Modified Davis grading:
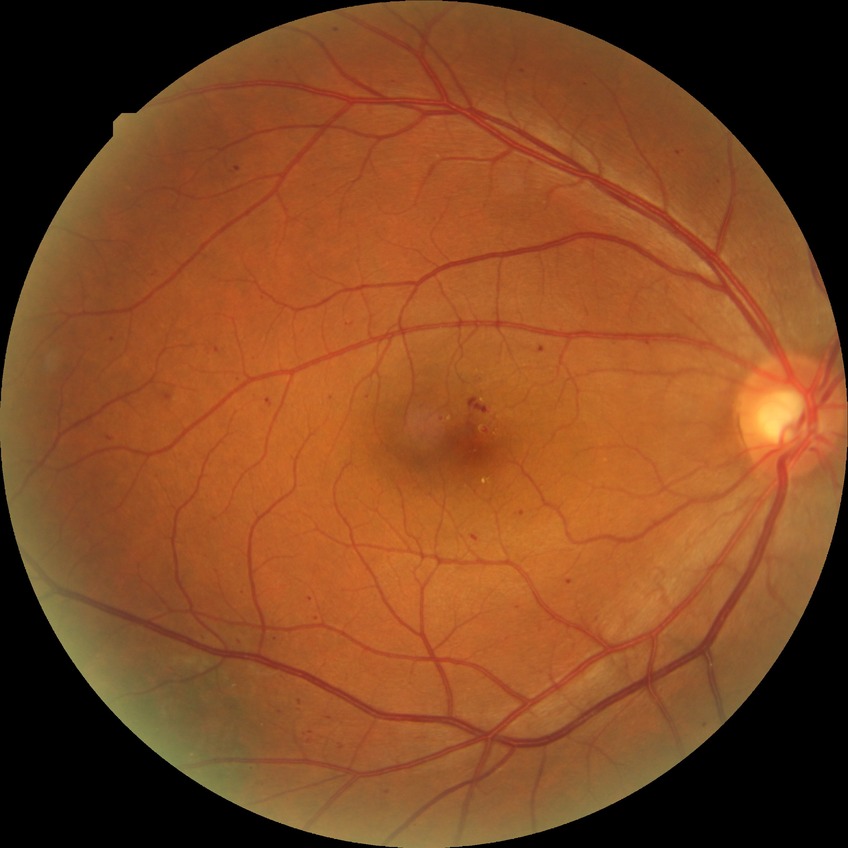
Disease class: non-proliferative diabetic retinopathy.
Diabetic retinopathy (DR) is SDR (simple diabetic retinopathy).